FOV: 45 degrees
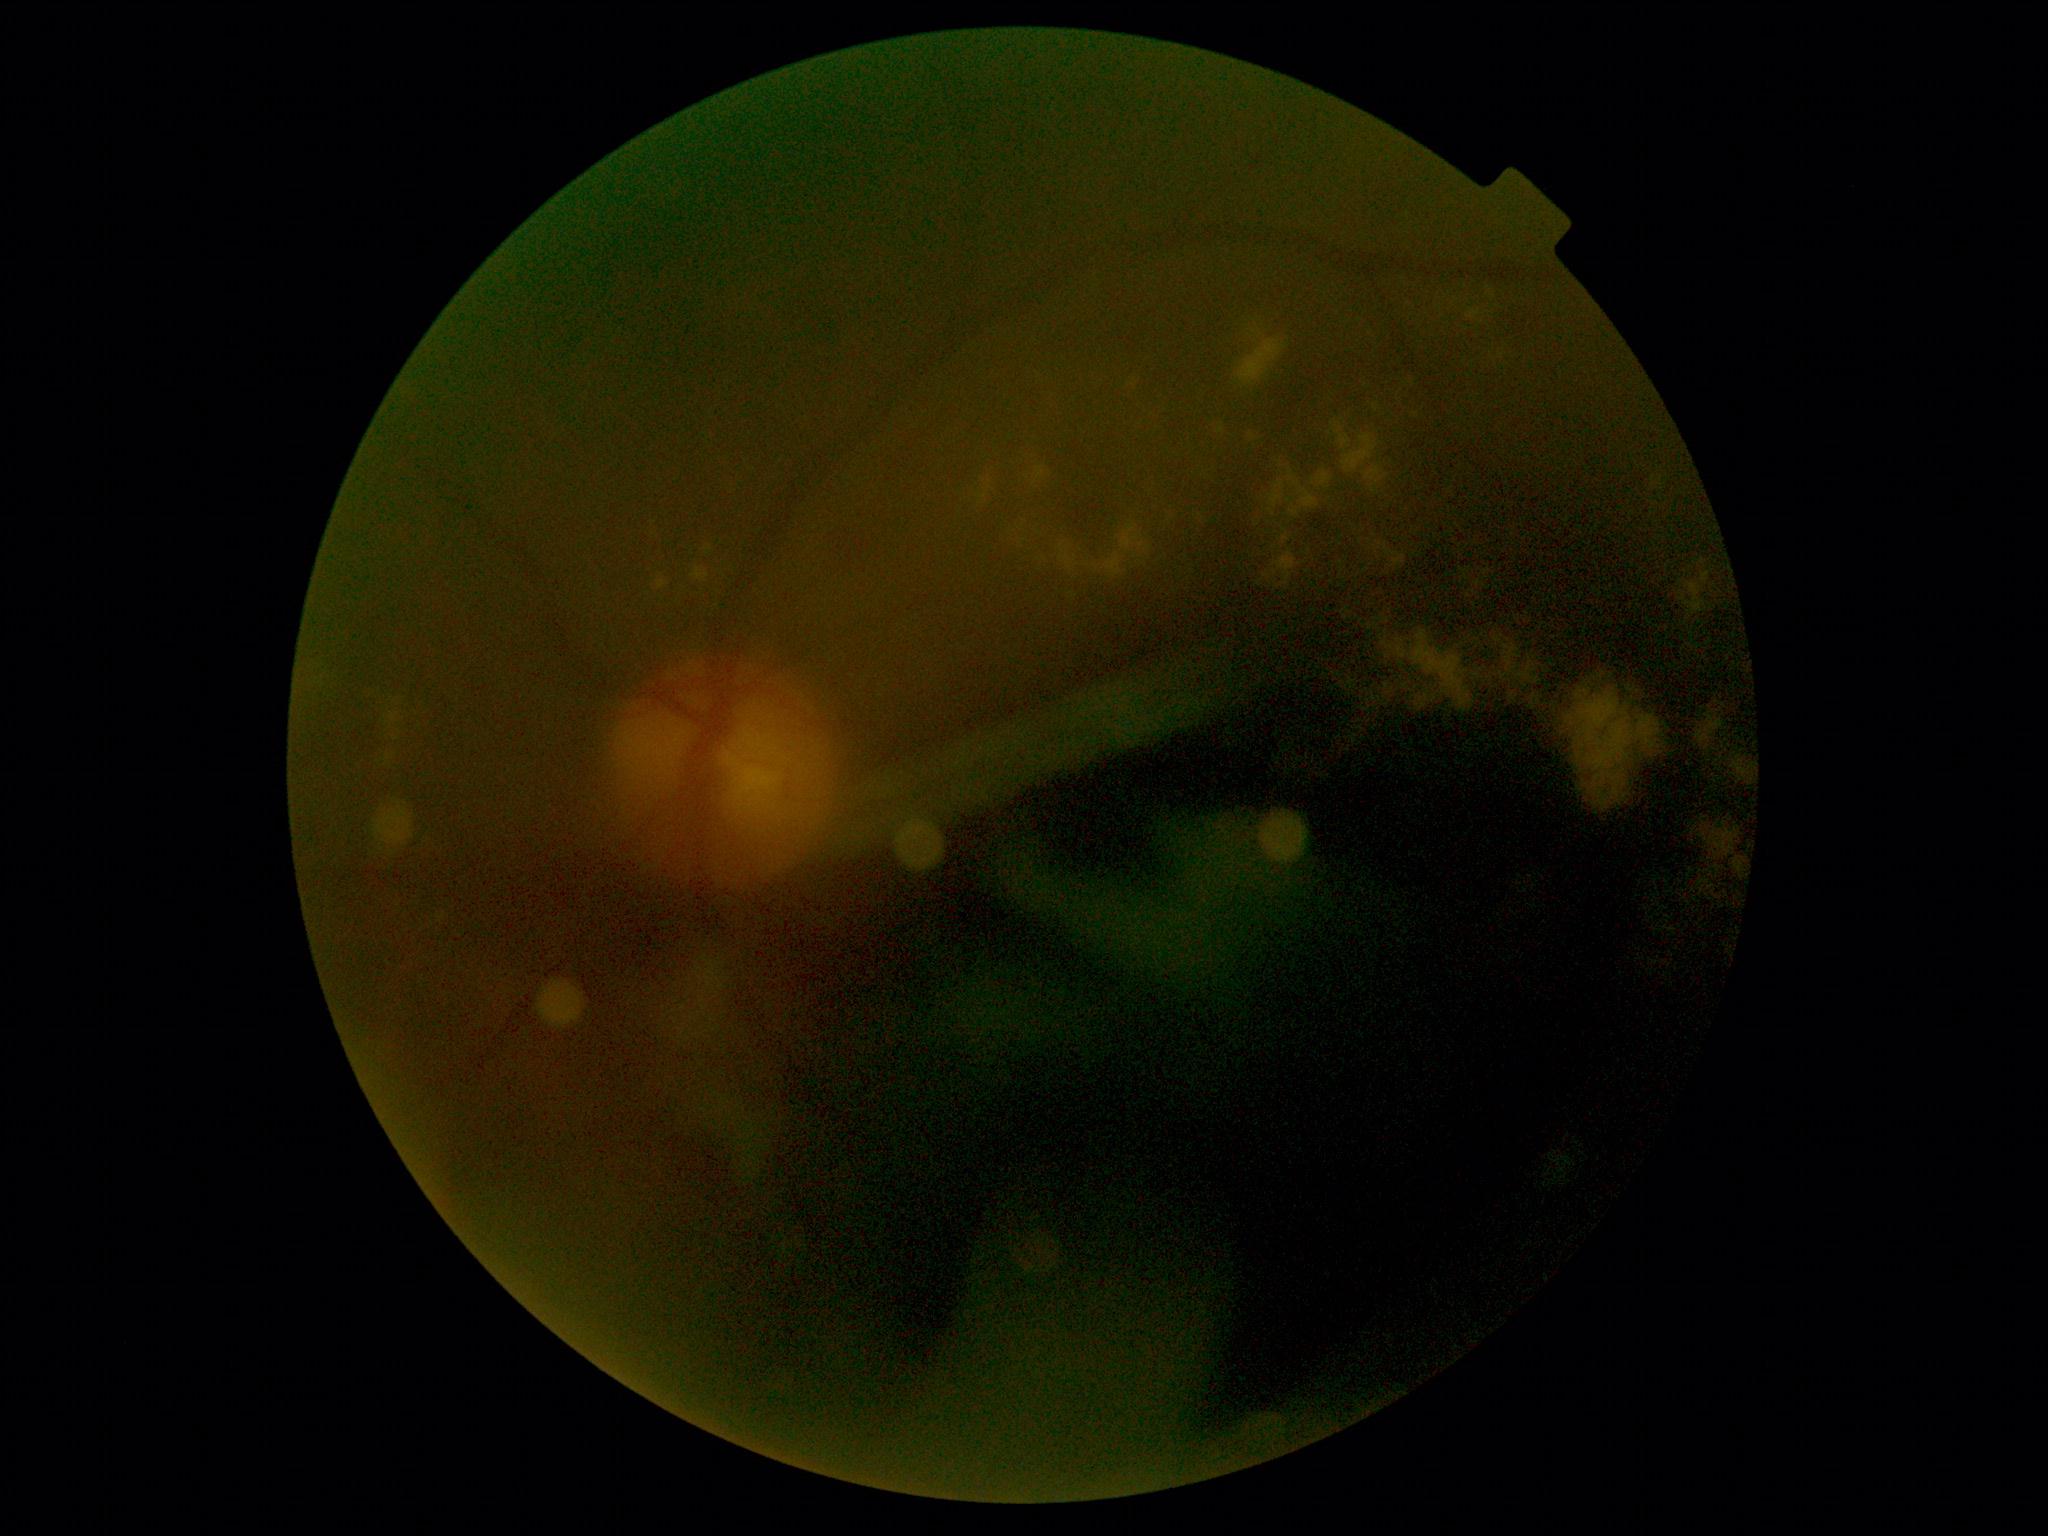
DR grade is moderate non-proliferative diabetic retinopathy (2).